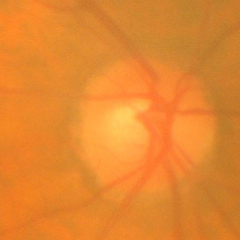

Fundus image with findings of no signs of glaucoma.